Color fundus image
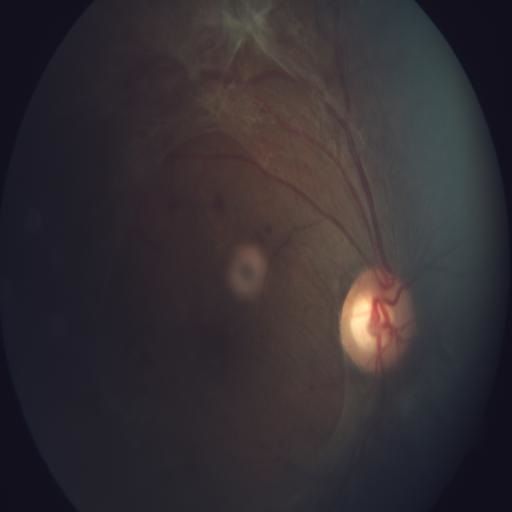

The image shows retinal traction, hemorrhagic retinopathy & optic disc cupping.